Acquired on the Phoenix ICON; Phoenix ICON wide-field infant fundus image: 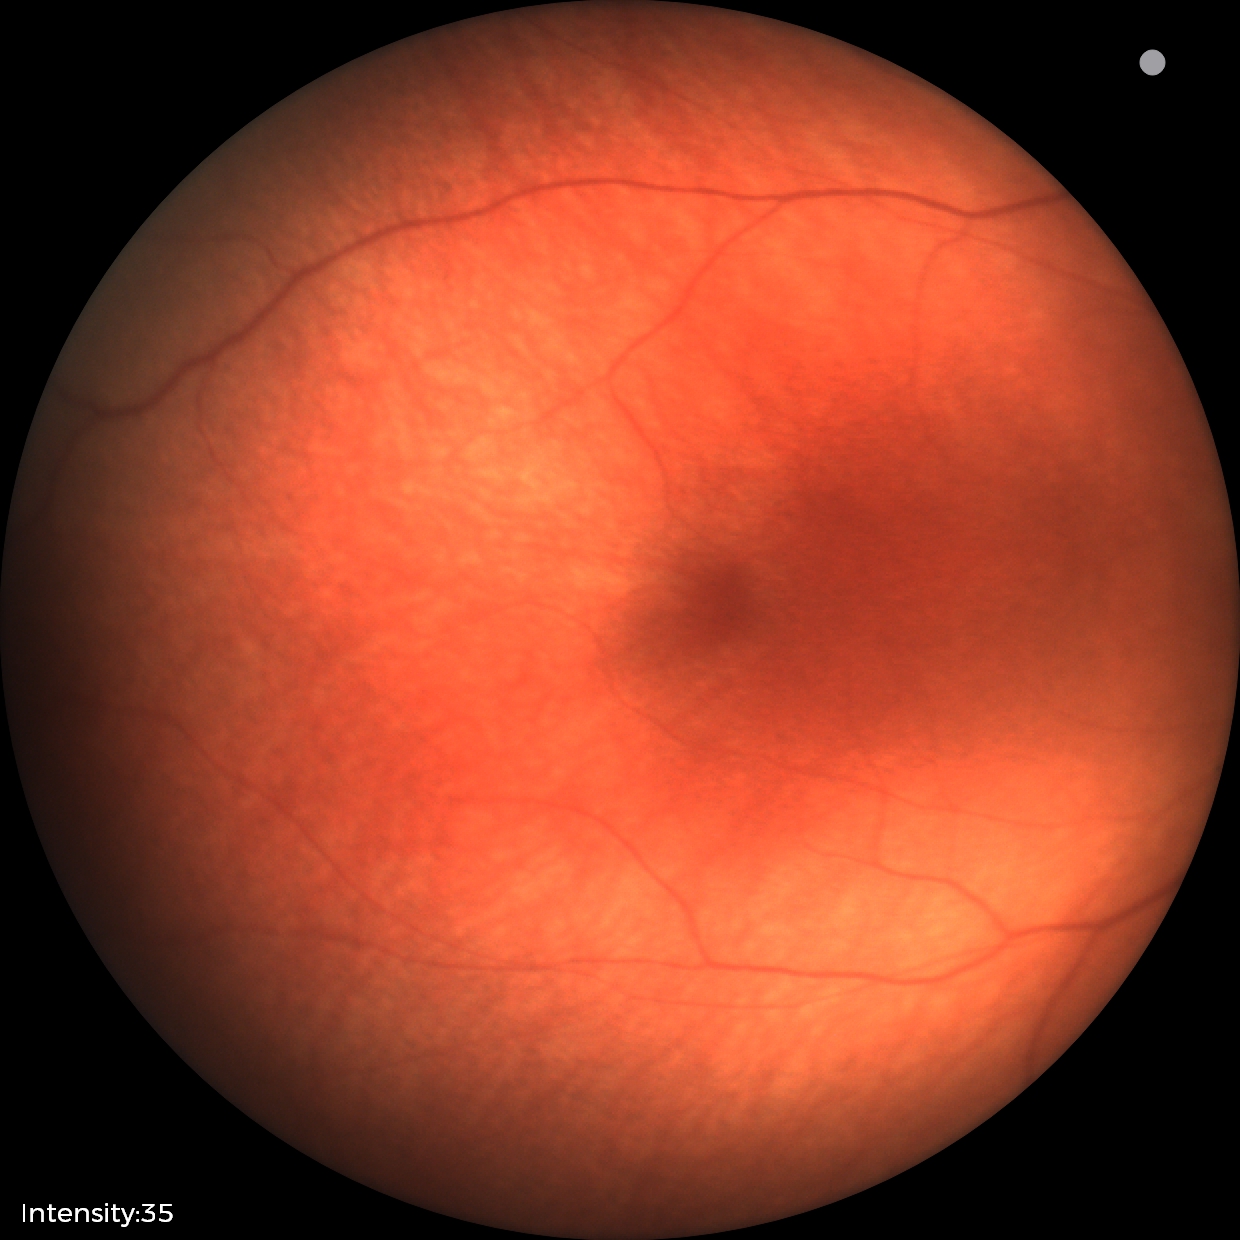 No retinal pathology identified on screening.